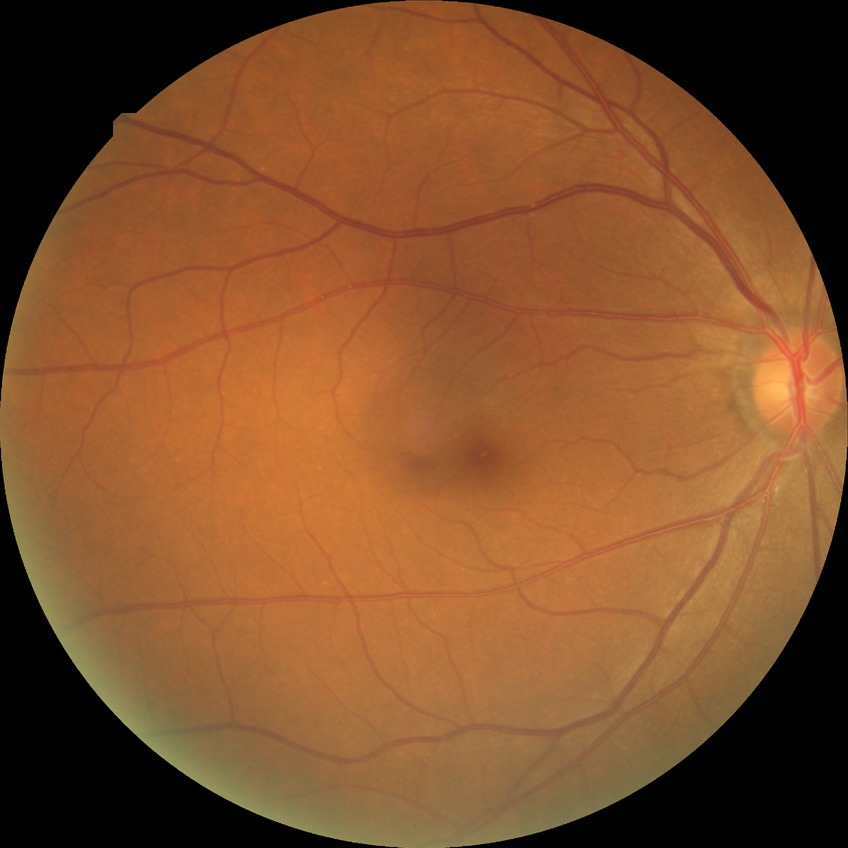 davis_grade: NDR